Captured after pupil dilation; 50° field of view.
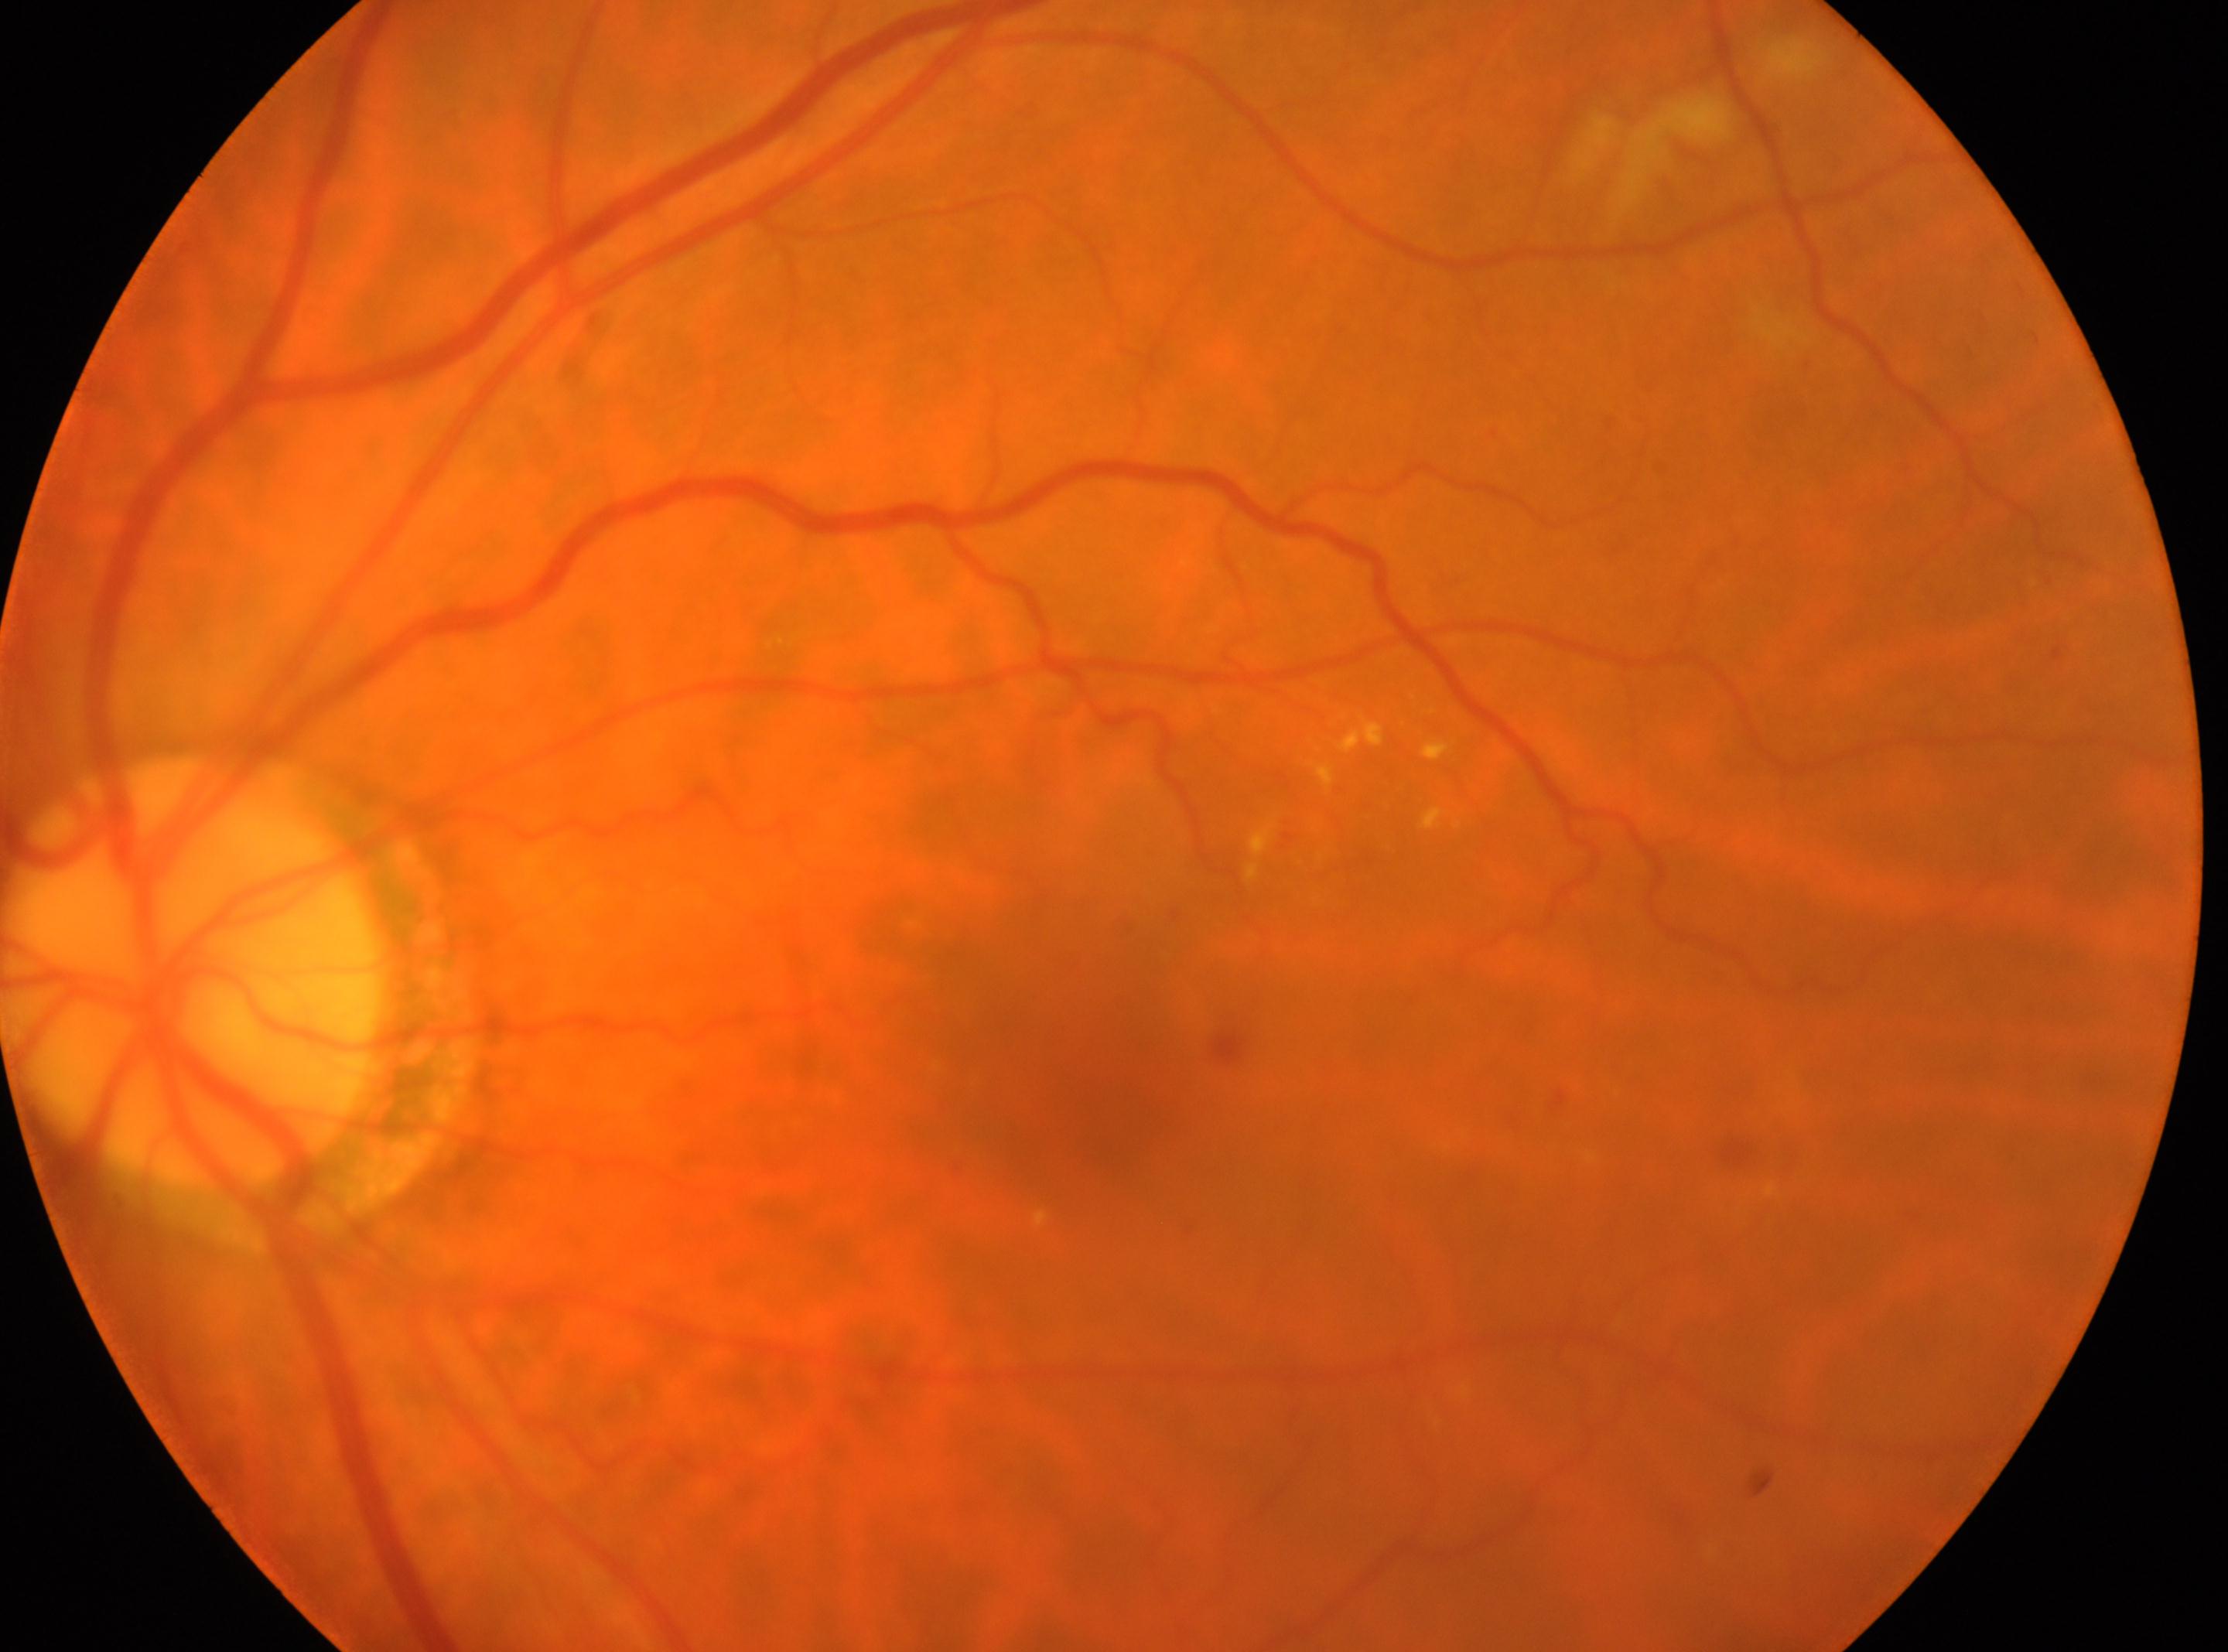 Diabetic retinopathy (DR) is moderate NPDR (grade 2). The optic disc is at (193, 971). This is the OS. The fovea center is at (1057, 1060).